Image size 848x848
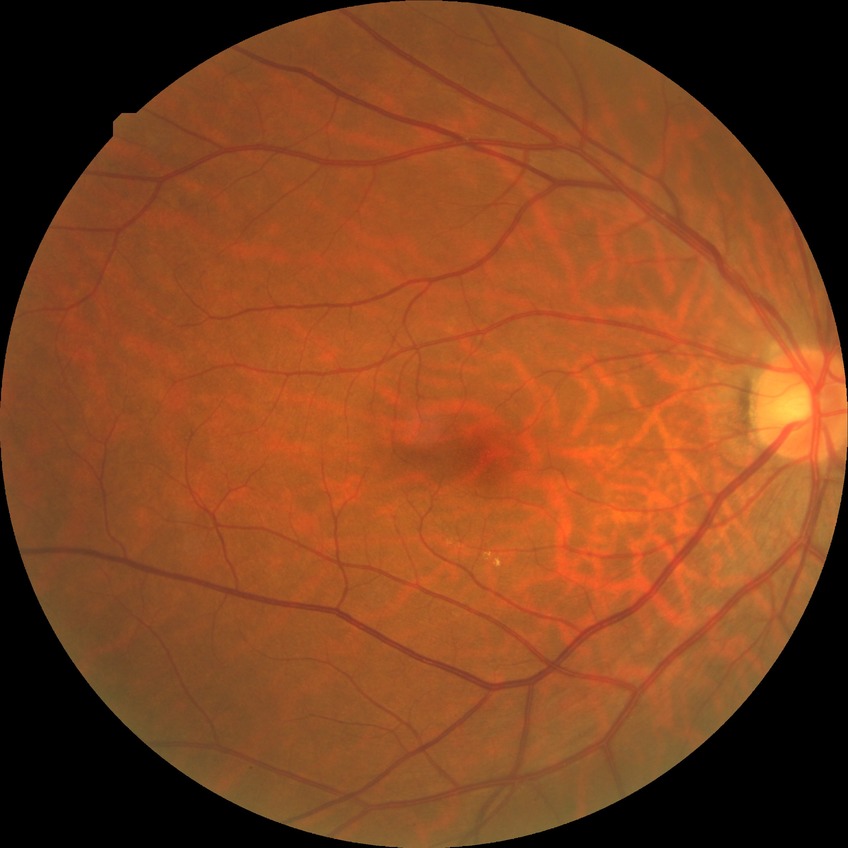
Modified Davis classification is no diabetic retinopathy.